CFP: 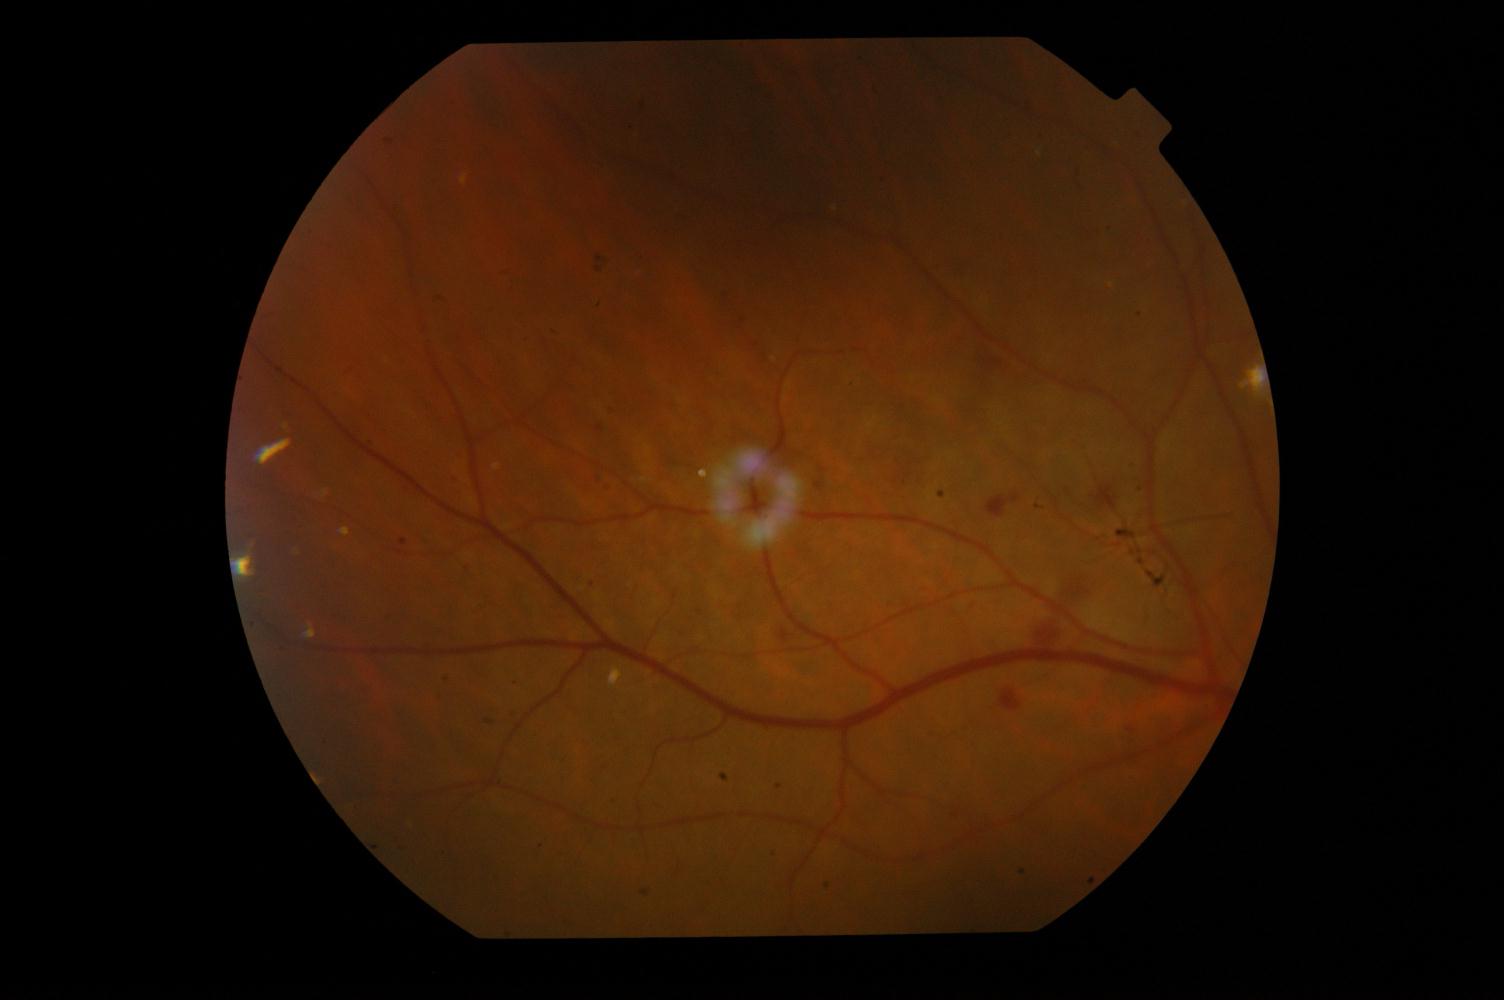 Pathology: diabetic retinopathy (DR).